Image size 1960x1897.
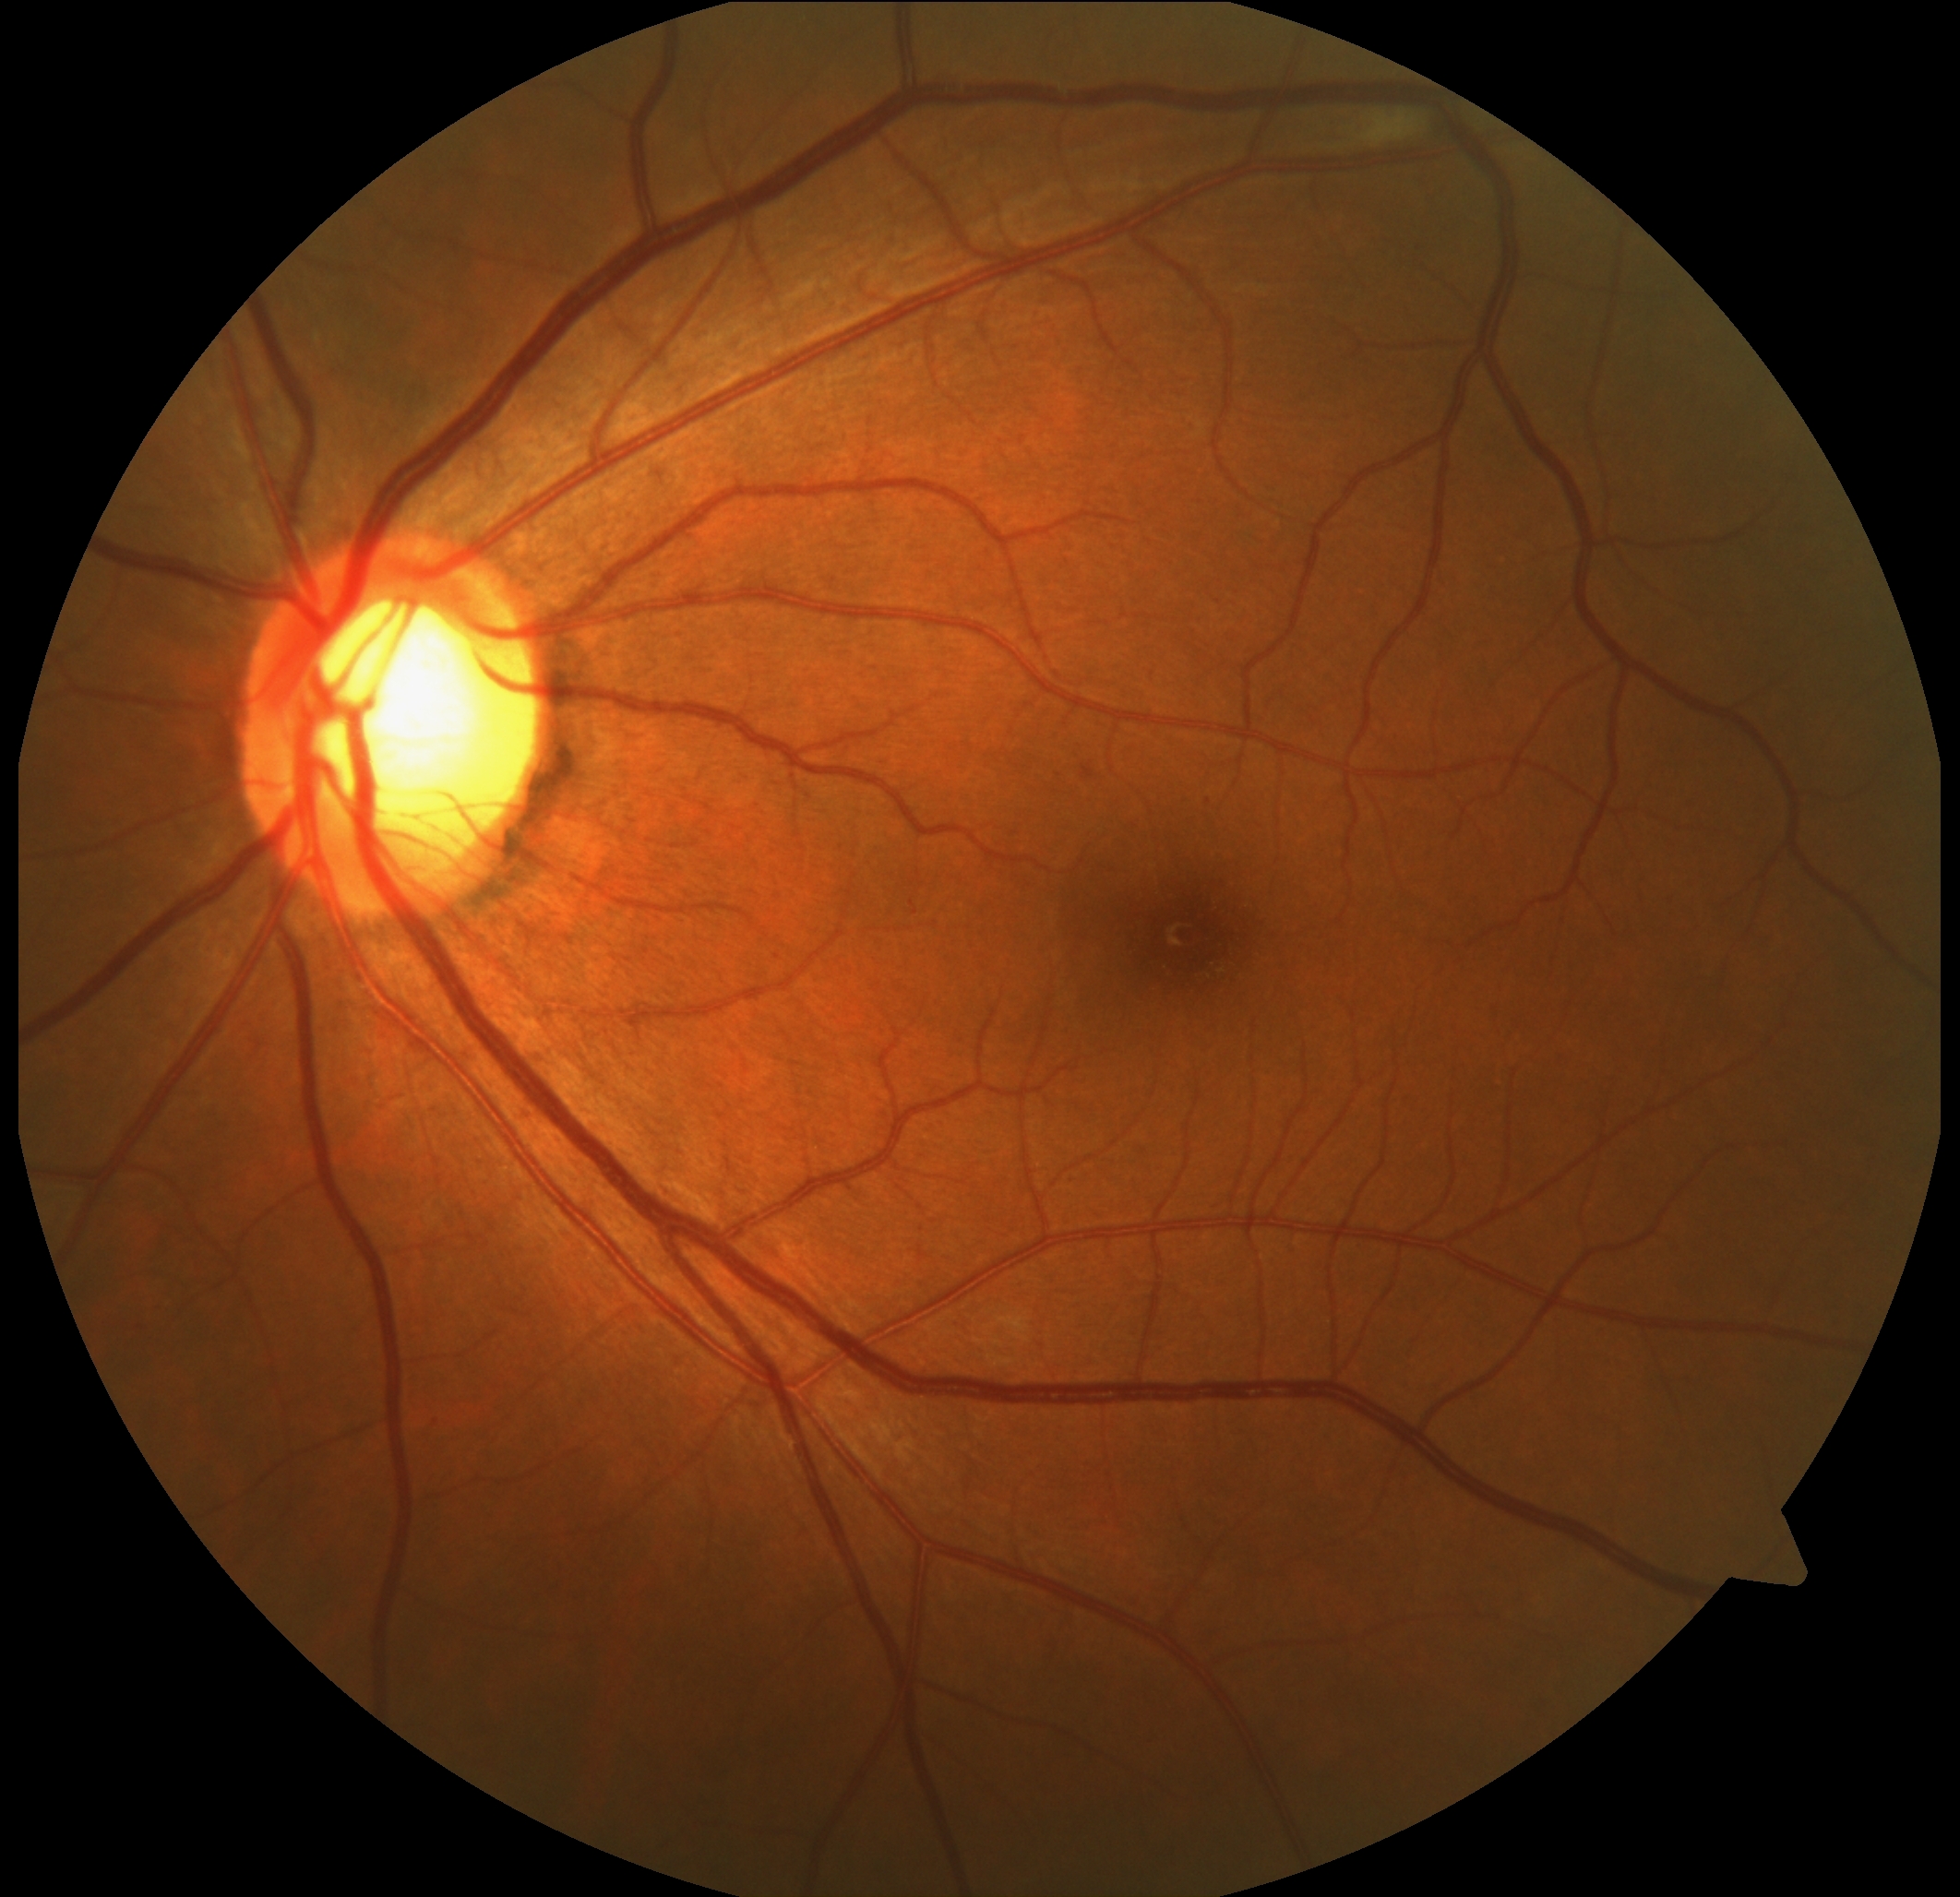
Annotations:
* diabetic retinopathy — grade 2 — more than just microaneurysms but less than severe NPDR